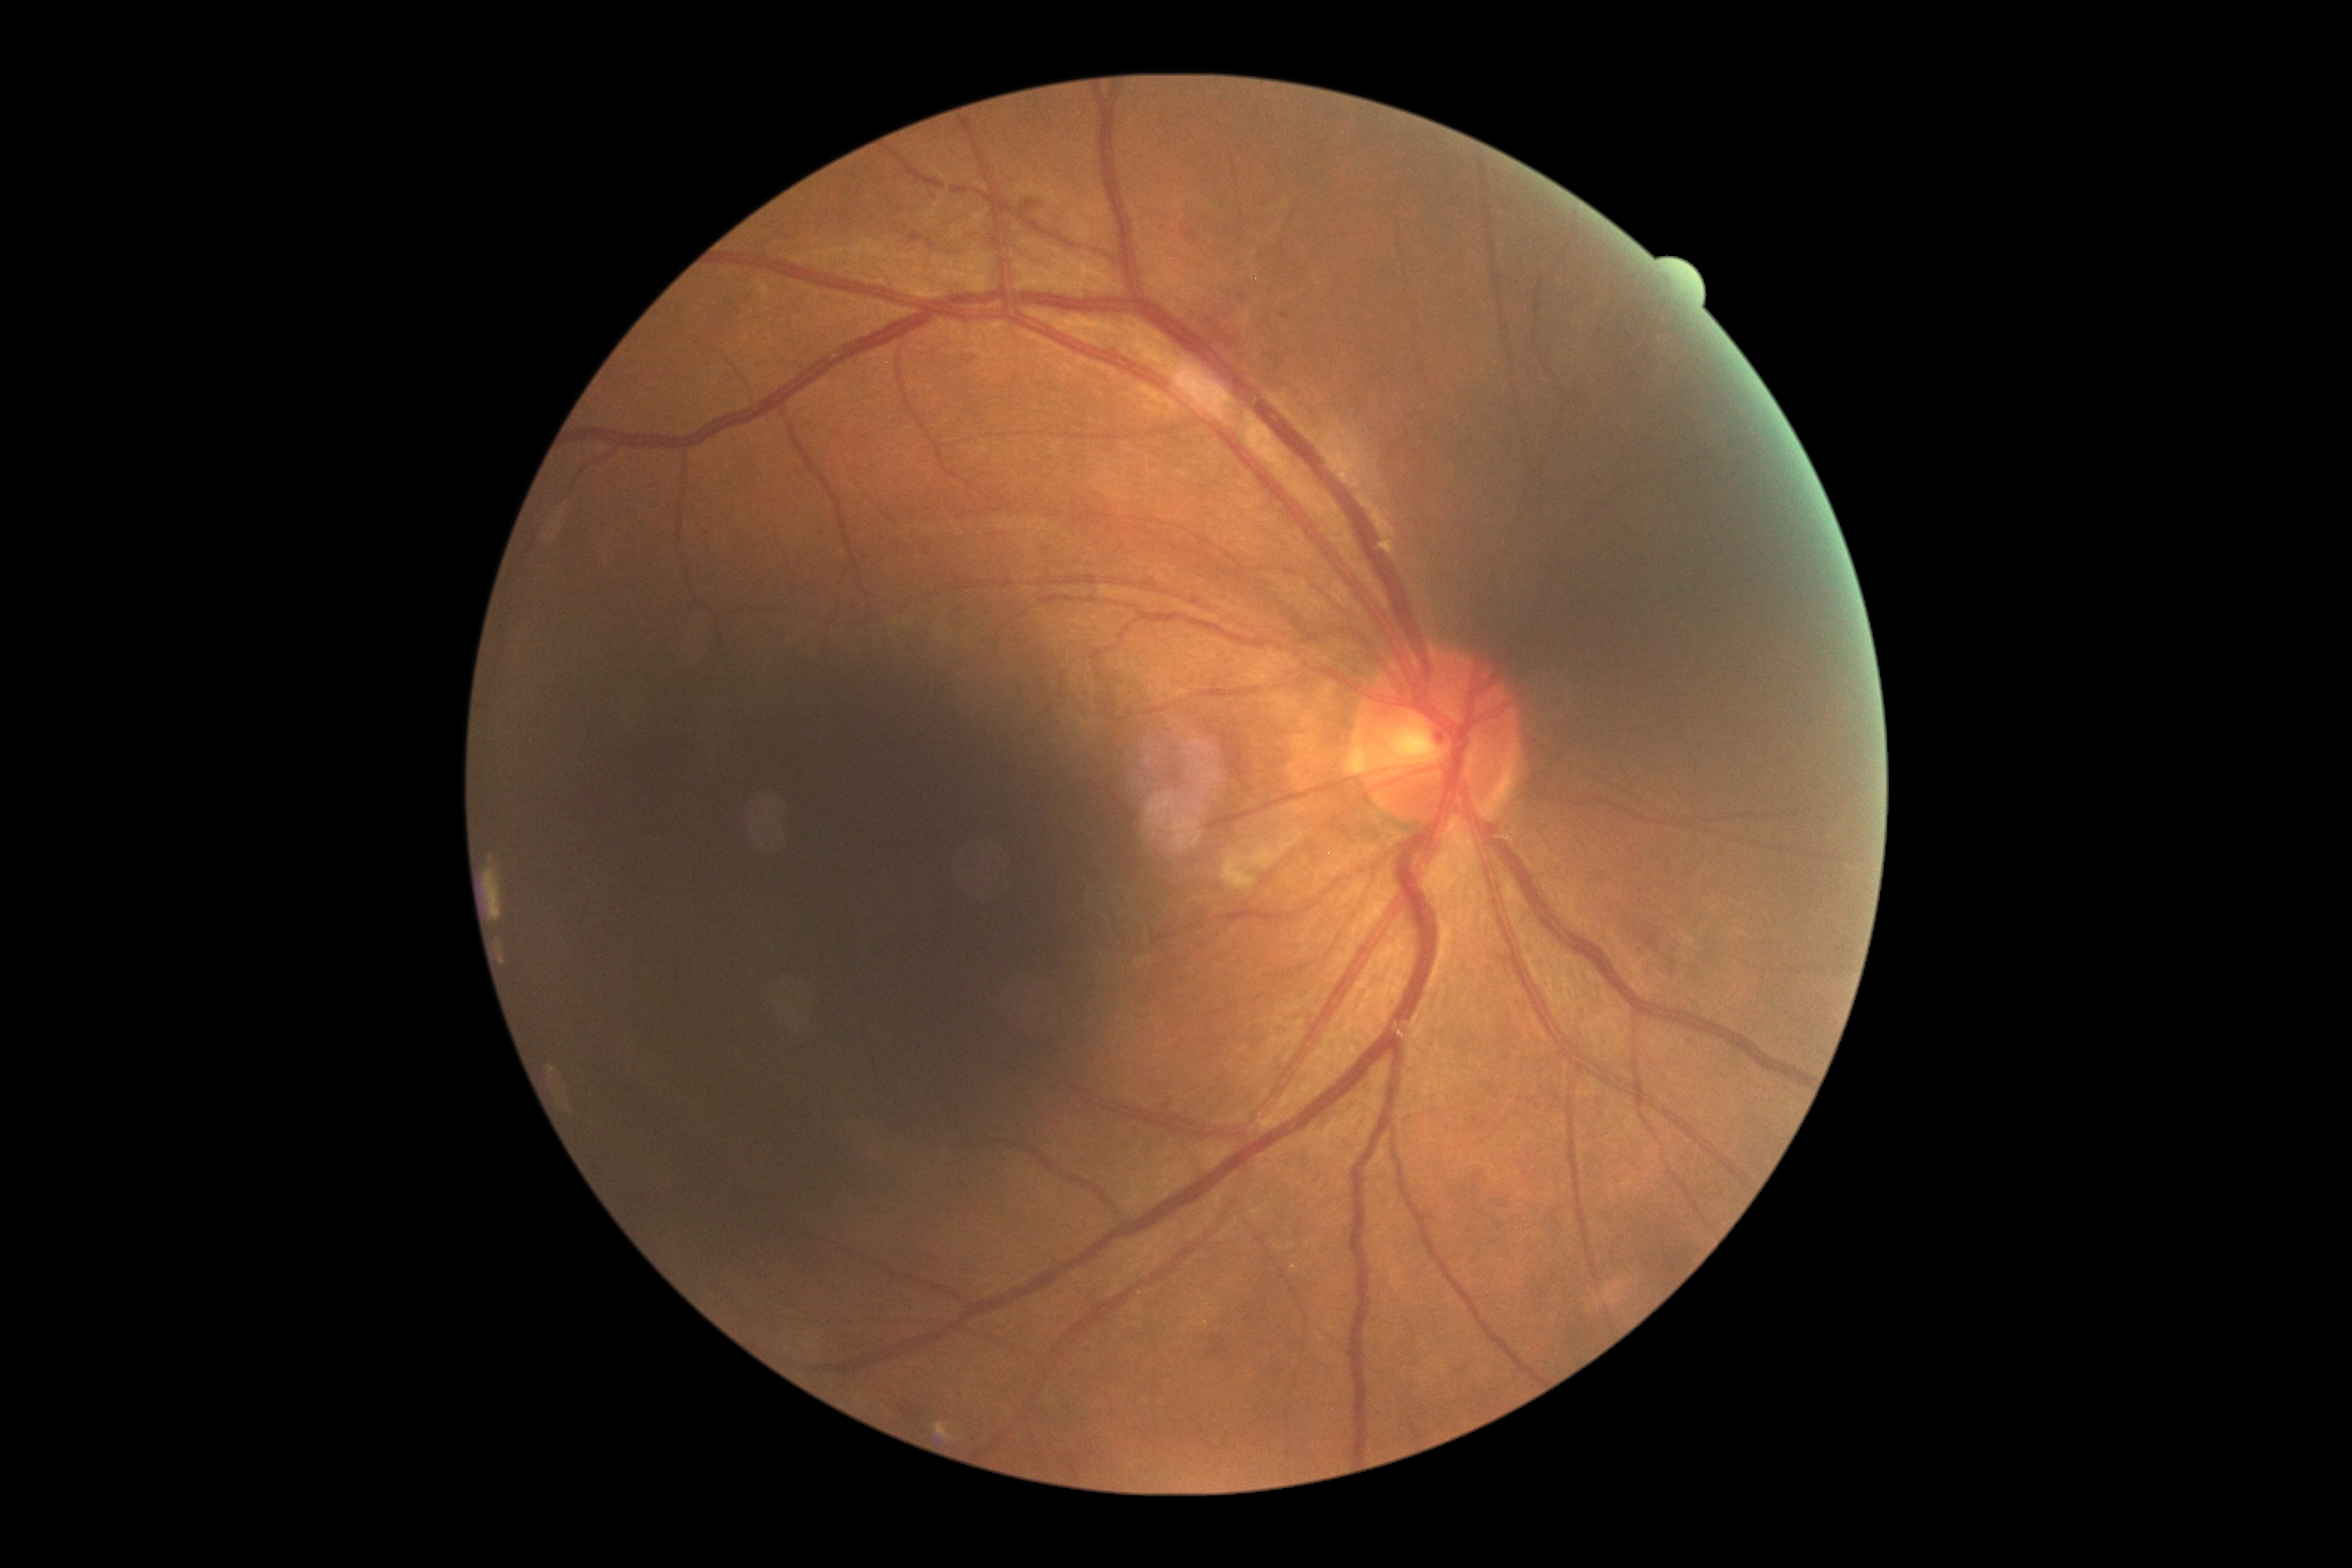

Findings:
- DR severity: grade 2 (moderate NPDR)